Fundus image cropped to the optic disc. 388 by 388 pixels
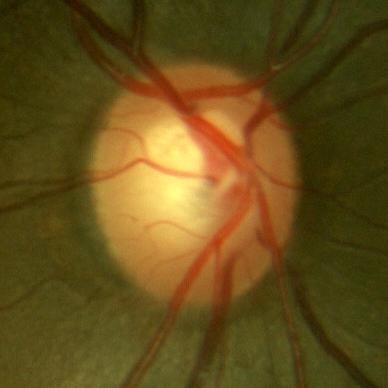 Q: Glaucoma assessment?
A: No — no glaucomatous damage.